No pharmacologic dilation; posterior pole photograph; FOV: 45 degrees; NIDEK AFC-230; 848 by 848 pixels — 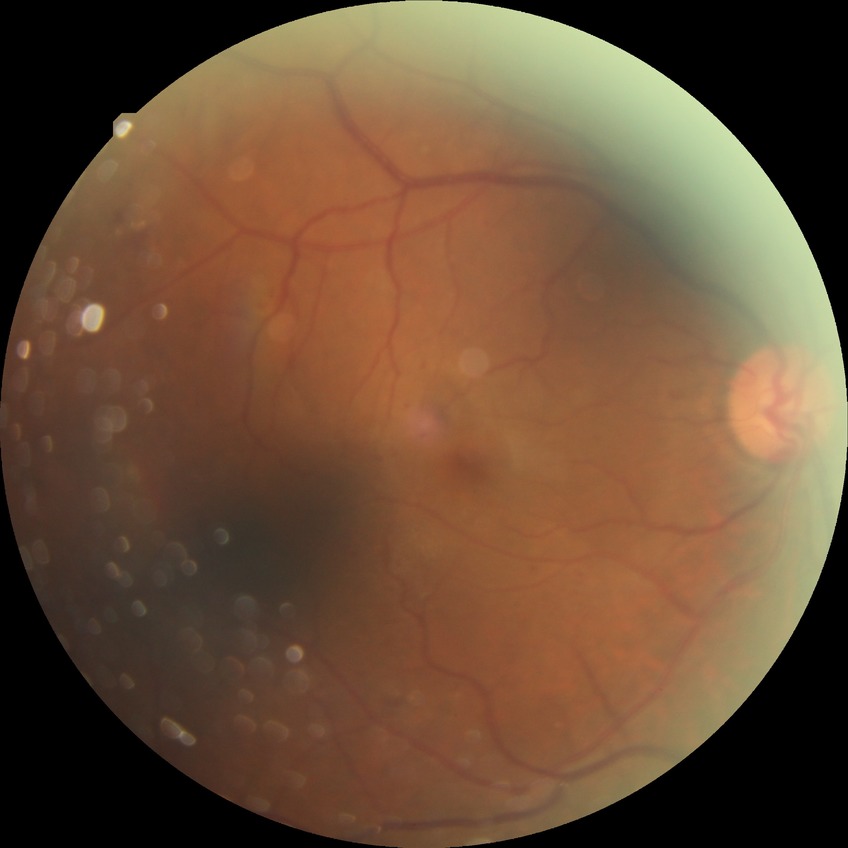

Diabetic retinopathy (DR): PDR (proliferative diabetic retinopathy).